No pharmacologic dilation: 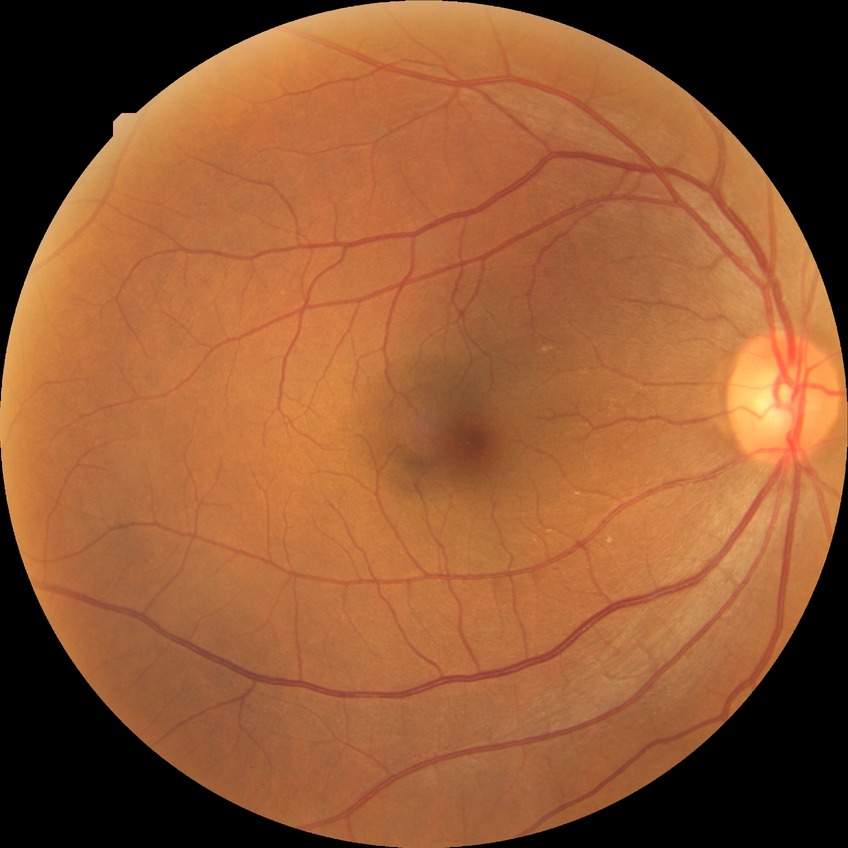 Diabetic retinopathy (DR): no diabetic retinopathy (NDR).